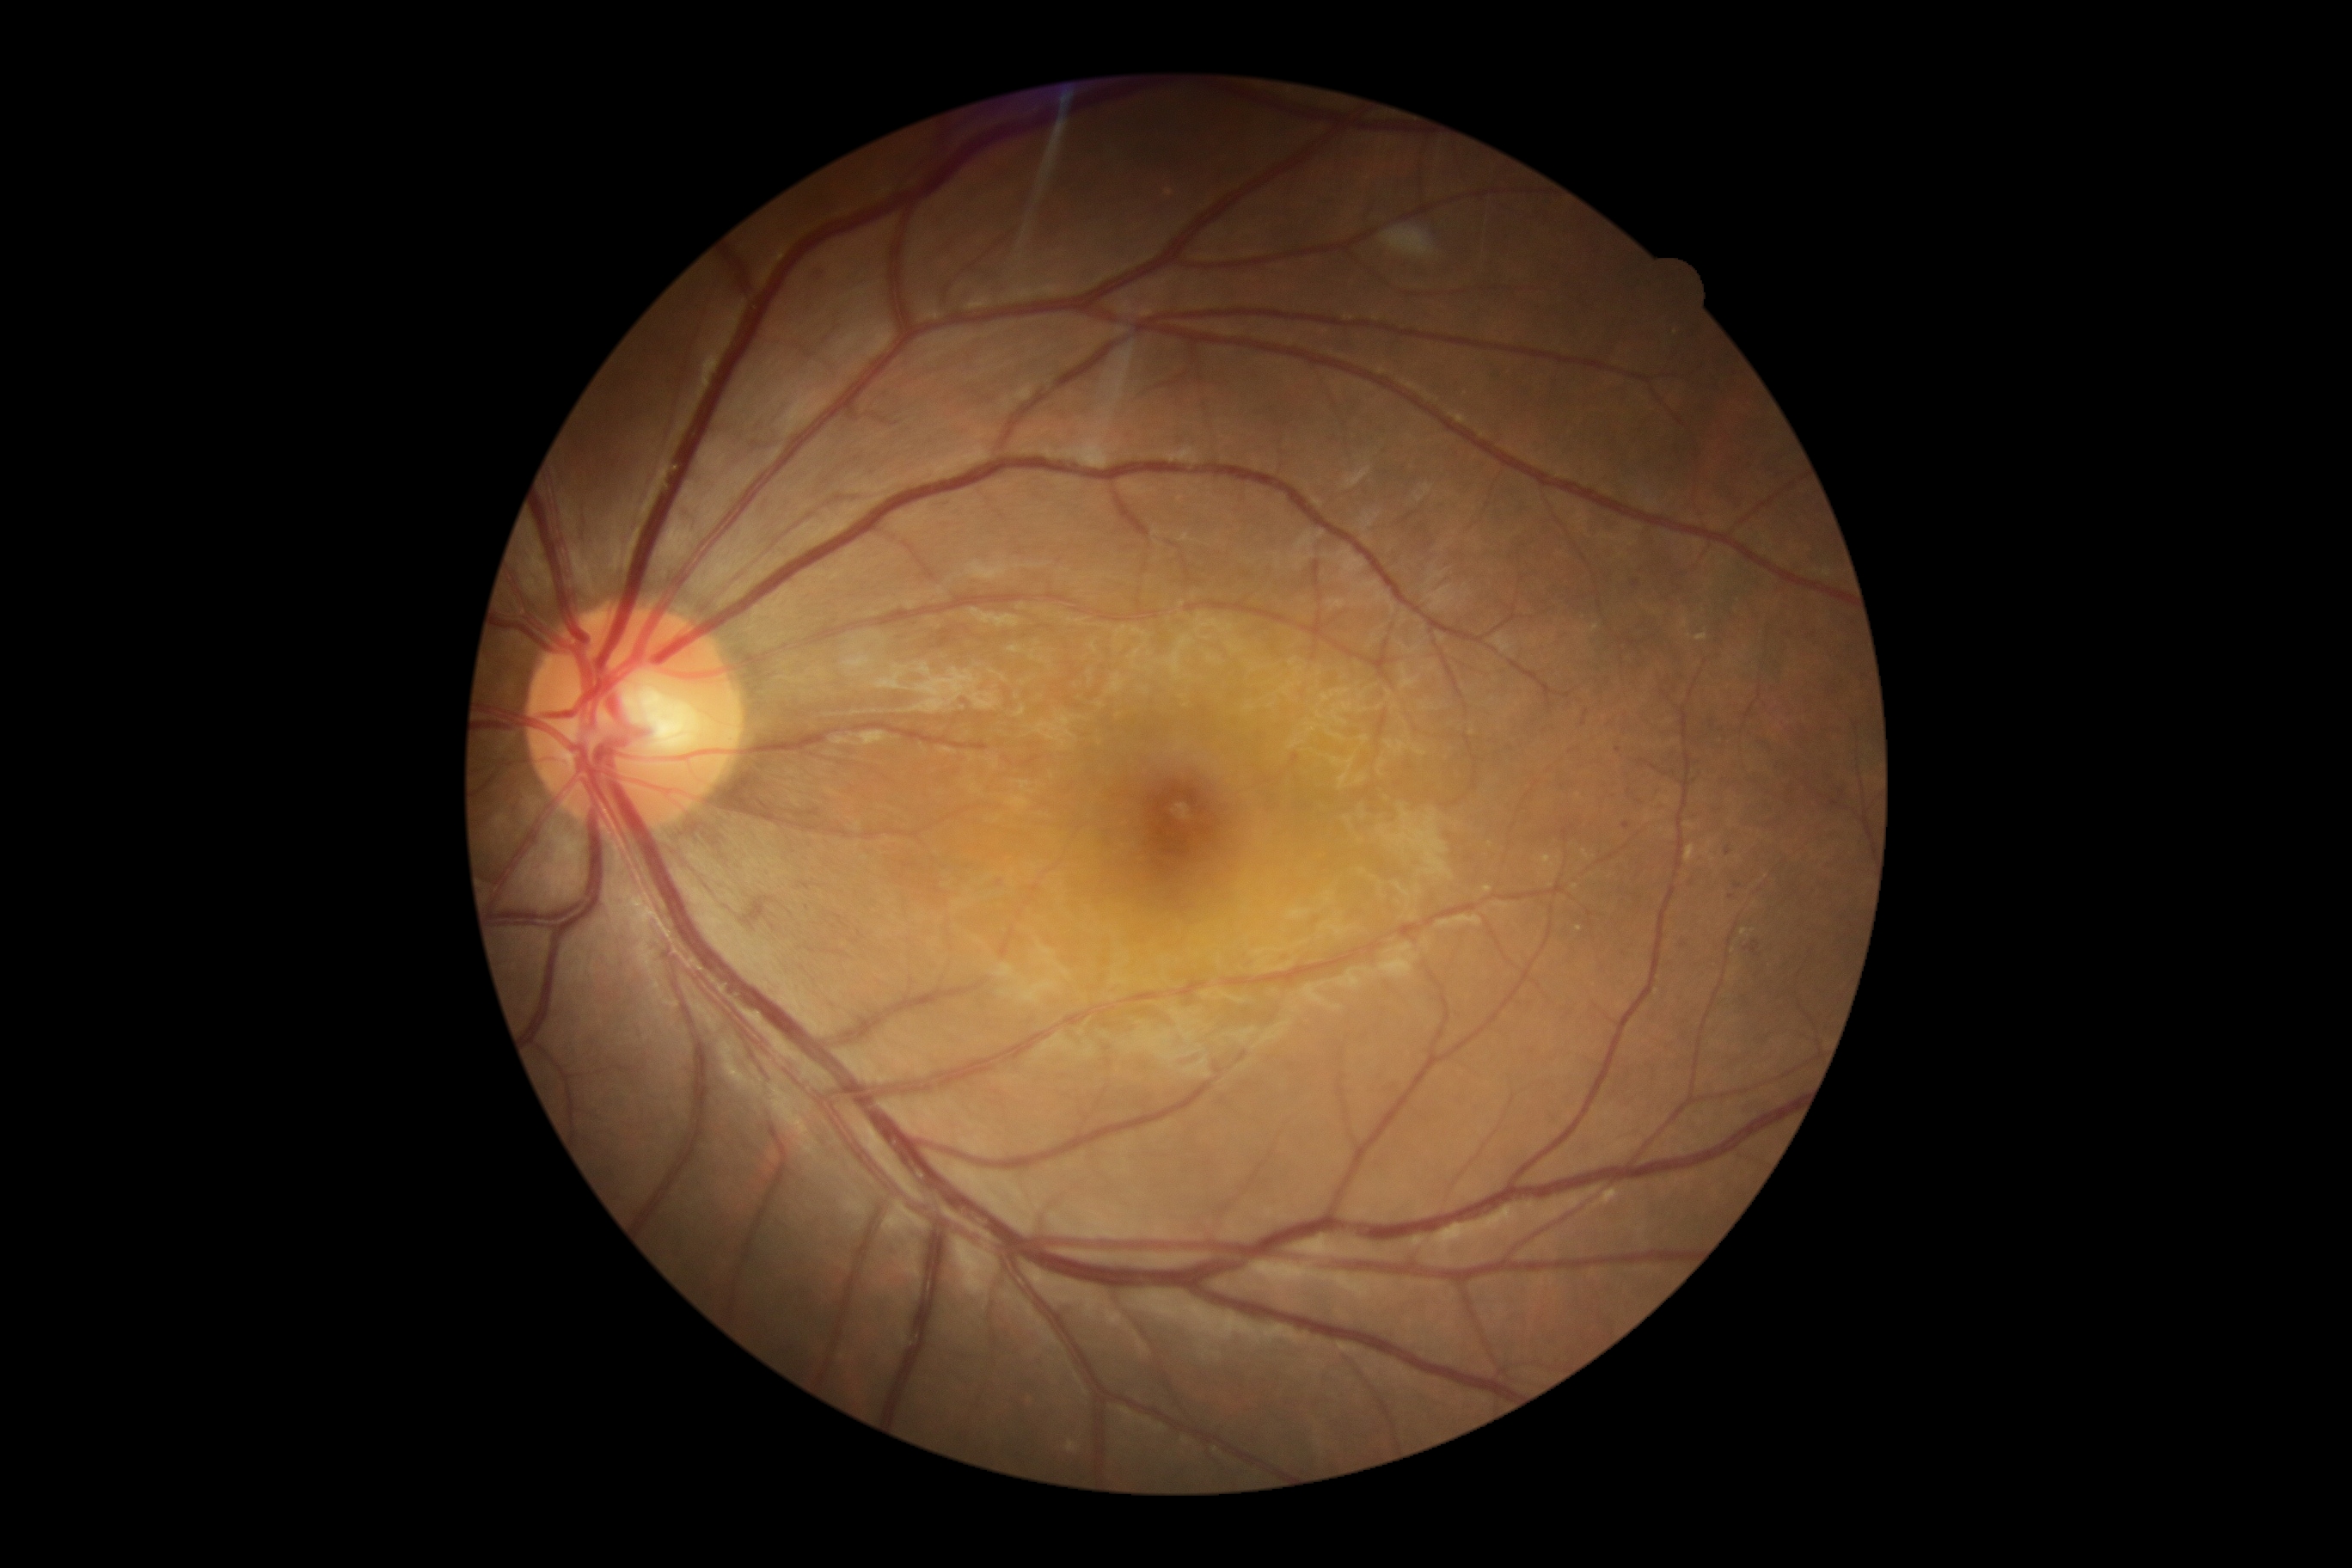
DR severity is 2/4. Disease class: non-proliferative diabetic retinopathy.